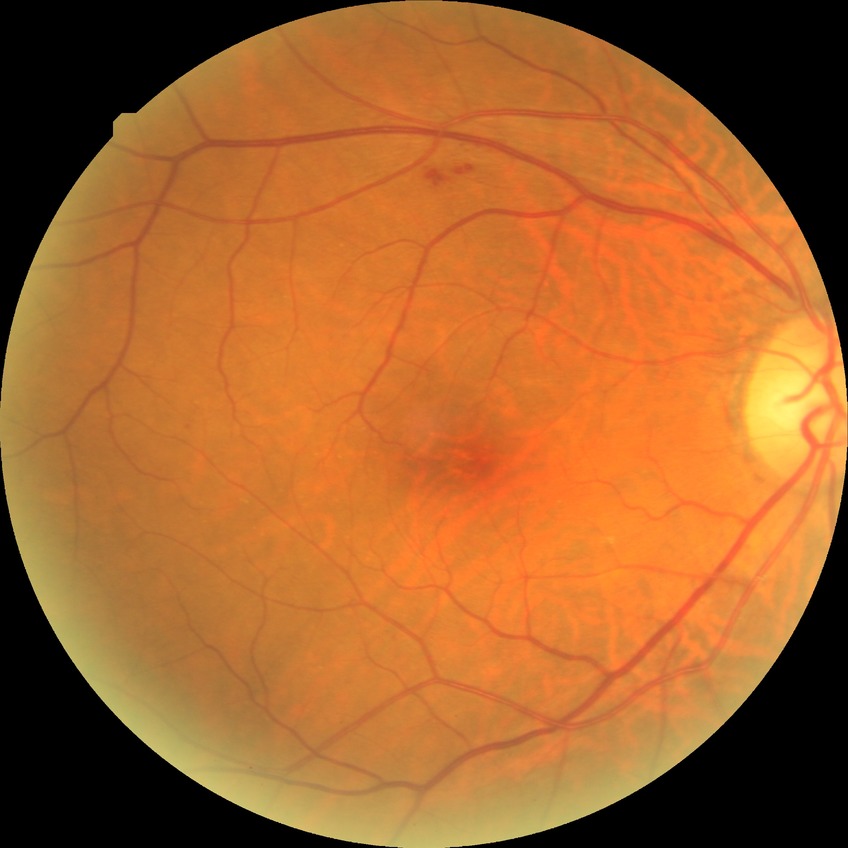
DR class=non-proliferative diabetic retinopathy, diabetic retinopathy (DR)=simple diabetic retinopathy (SDR).